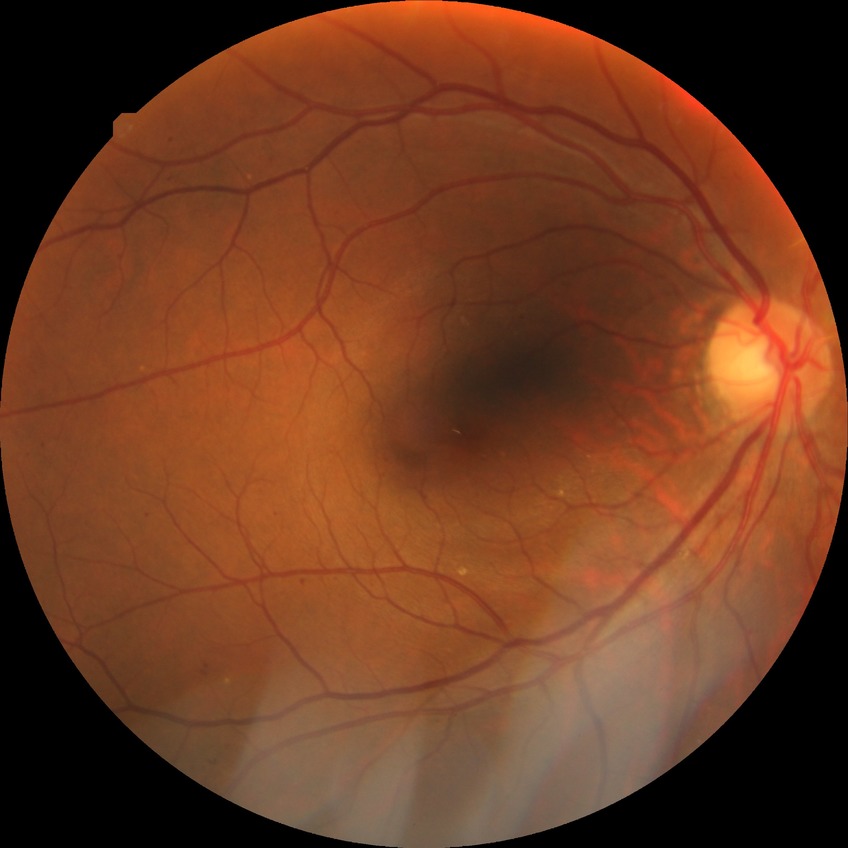 DR class: non-proliferative diabetic retinopathy.
DR stage is SDR.